Retinal fundus photograph — 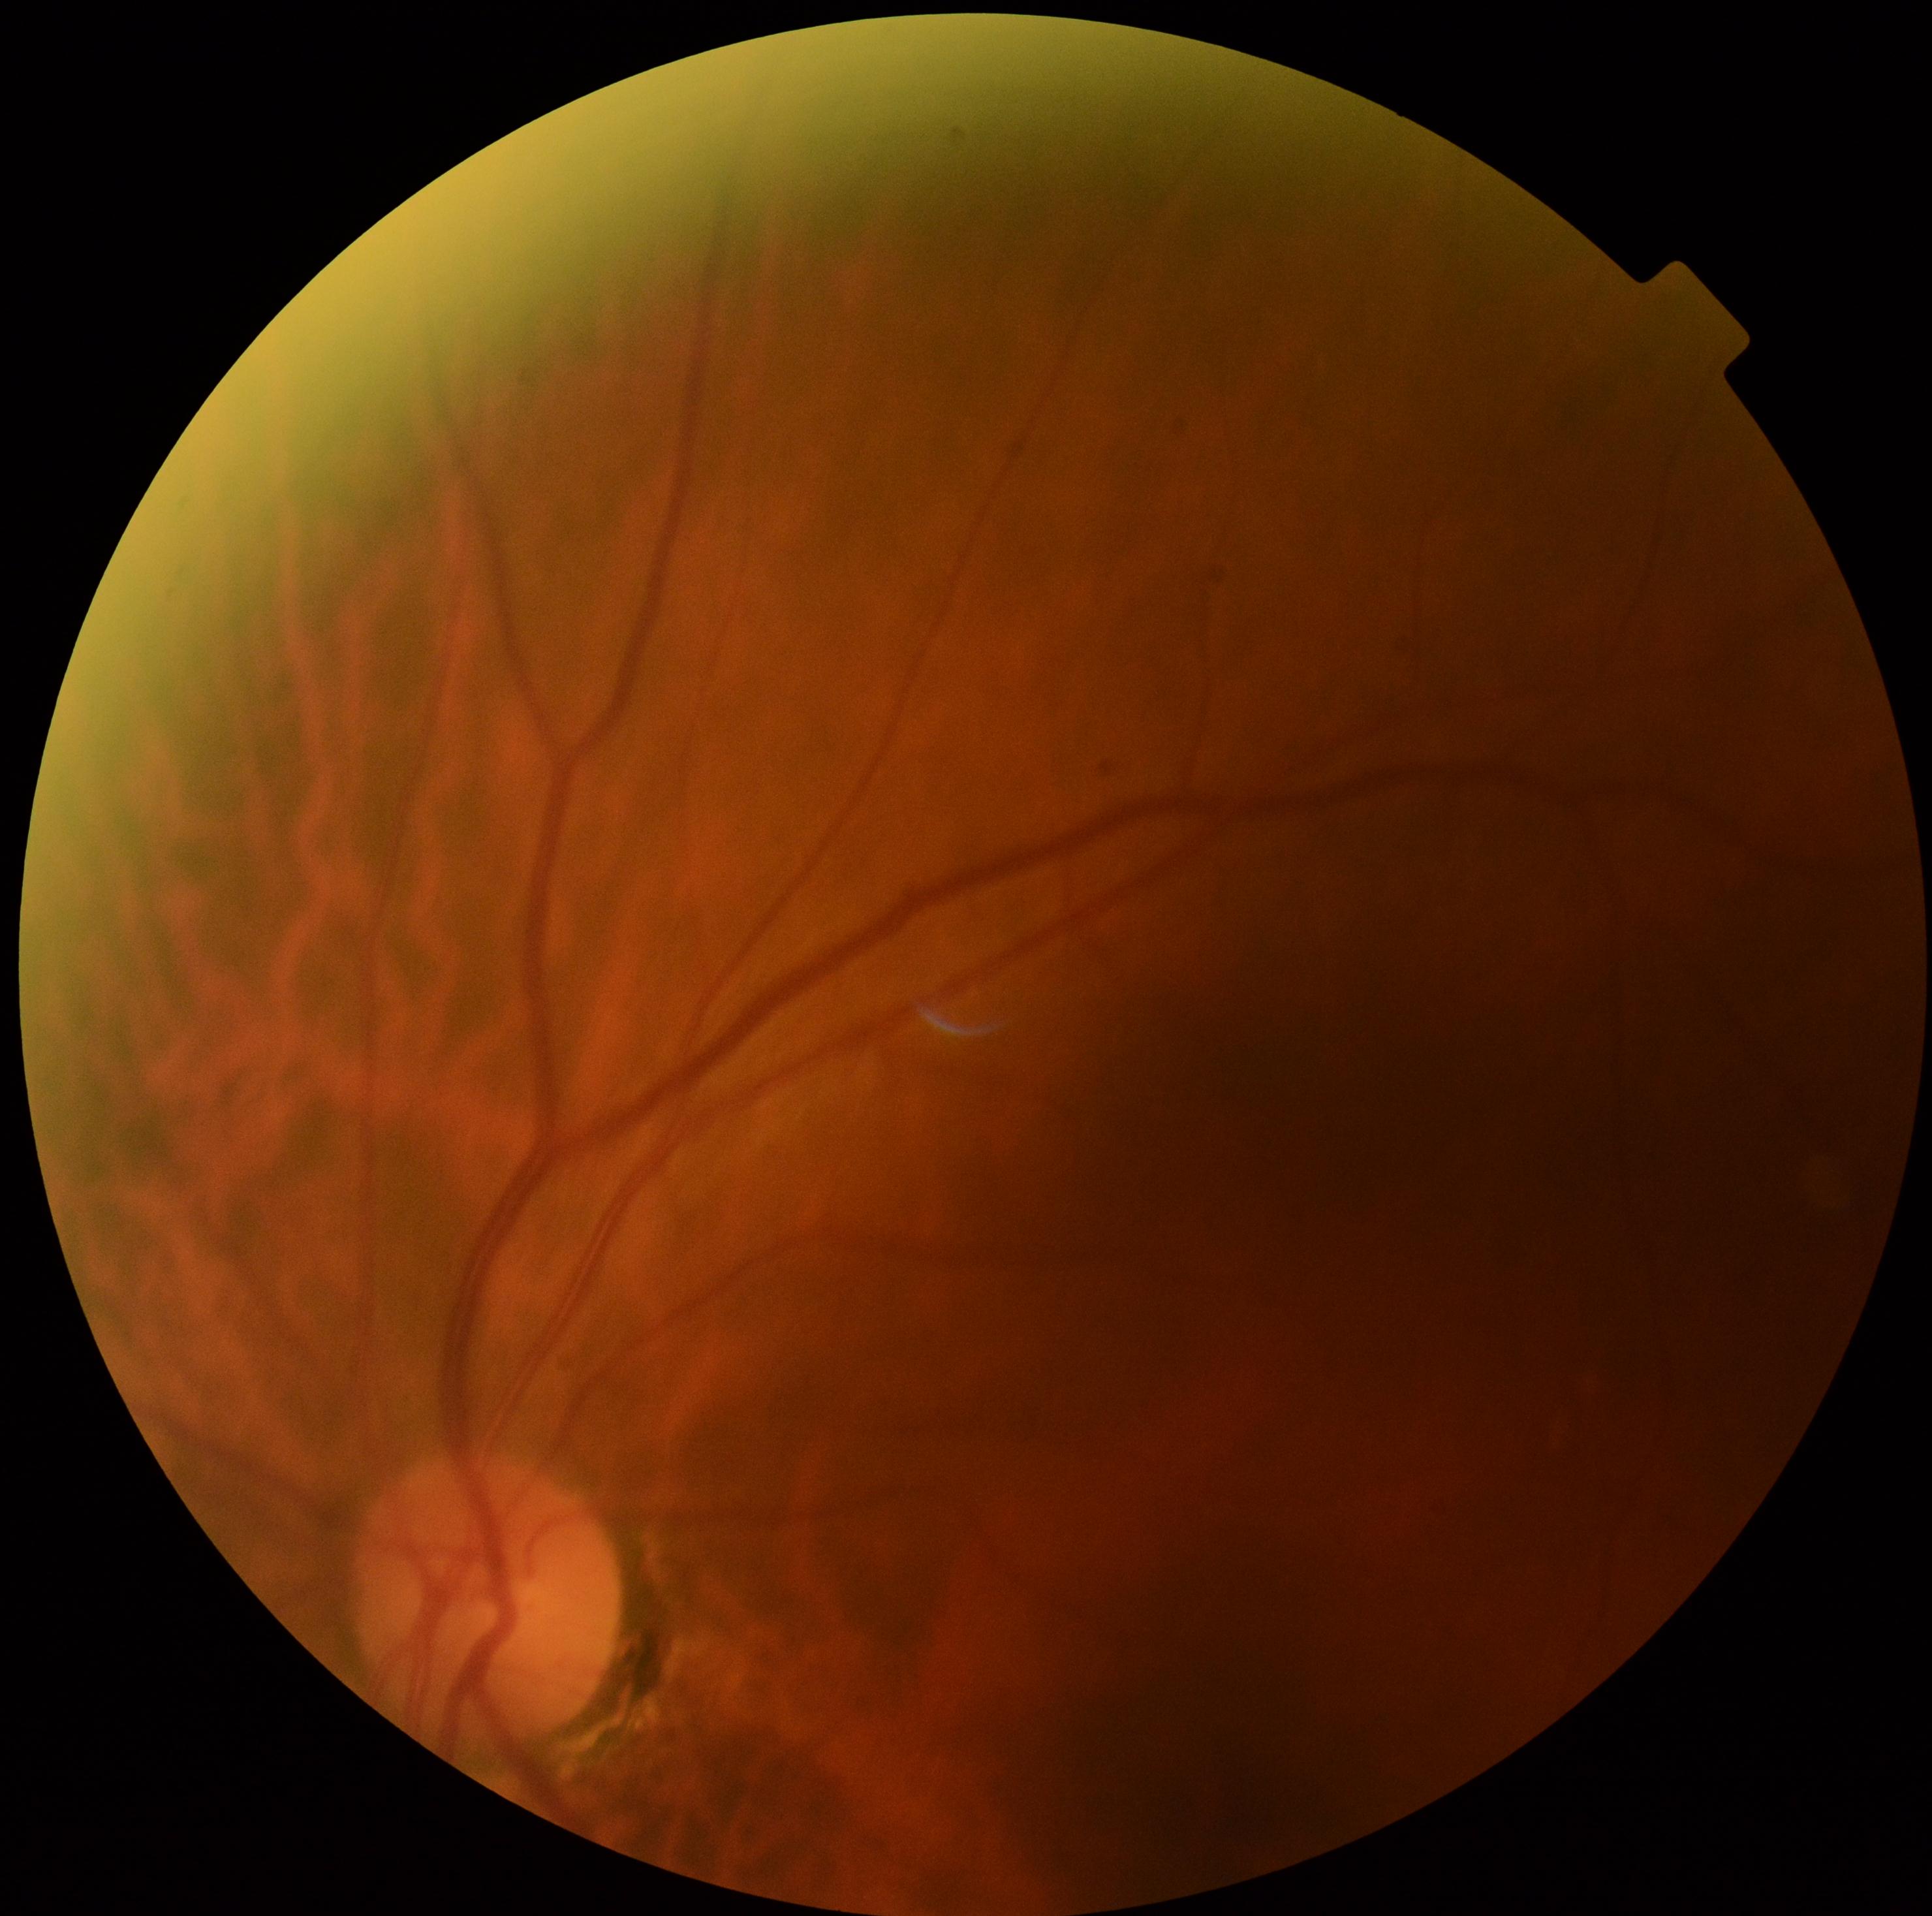

DR severity: 0/4. No apparent diabetic retinopathy.